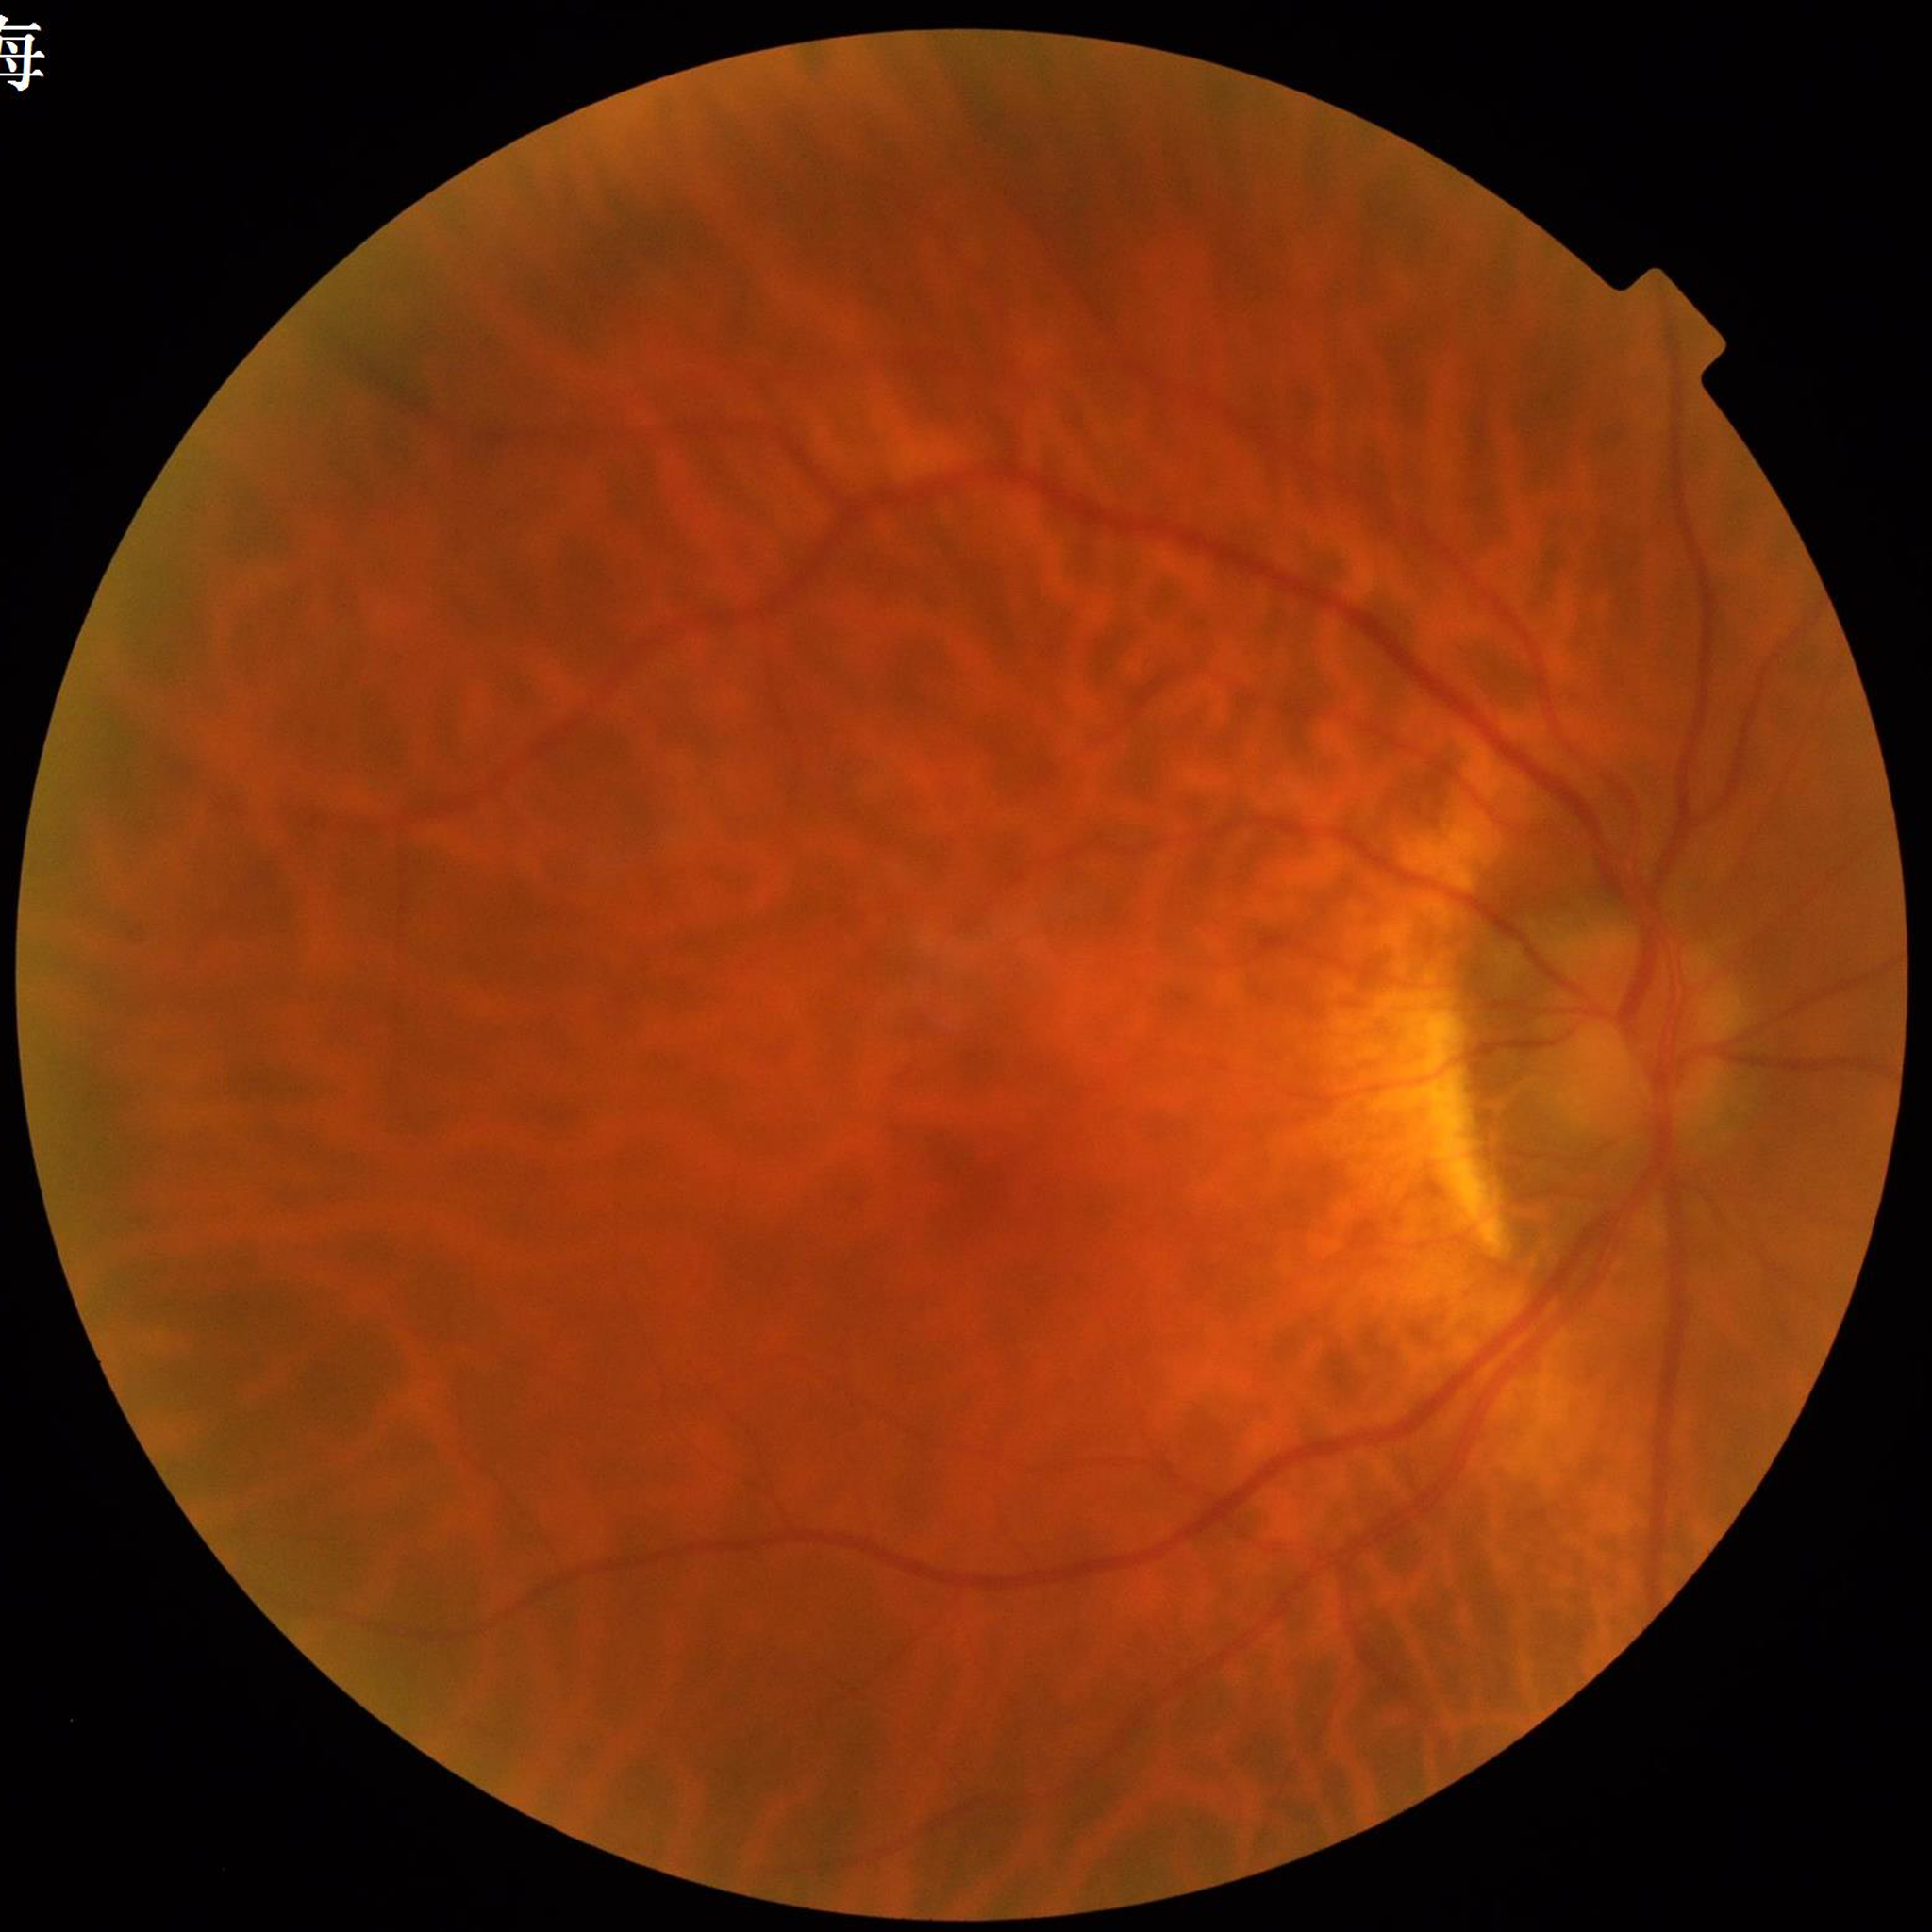 Disease class: diabetic retinopathy
Quality assessment: blur present, illumination and color satisfactory, contrast adequate